Pediatric wide-field fundus photograph. Captured with the Natus RetCam Envision (130° field of view)
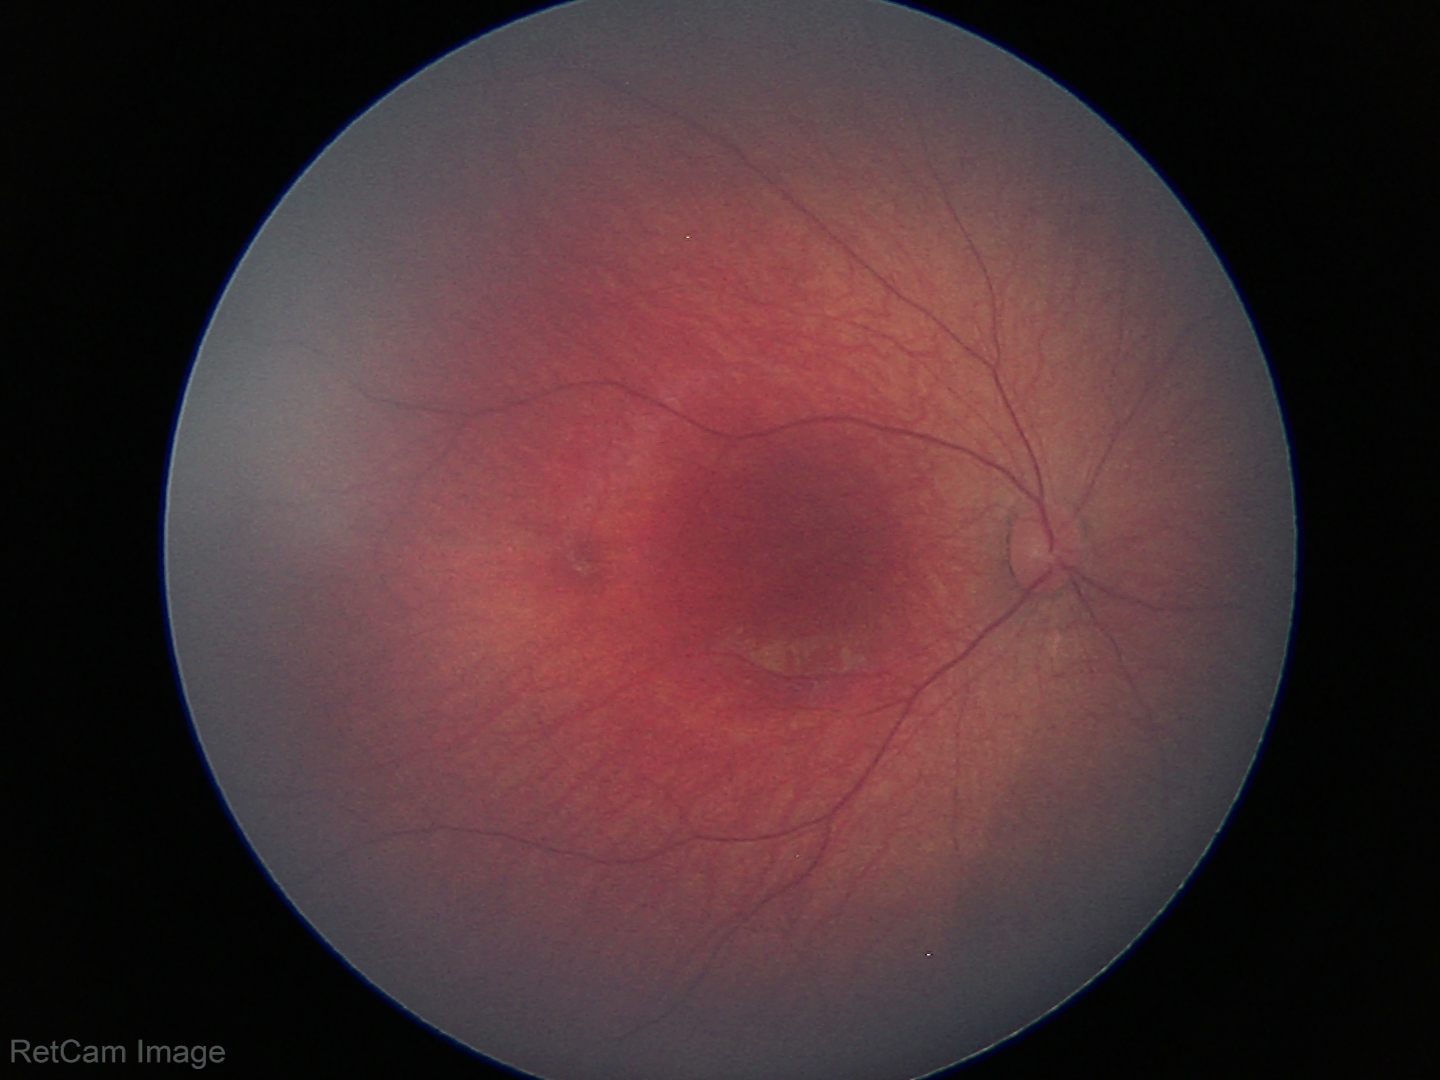 Examination with physiological retinal findings.